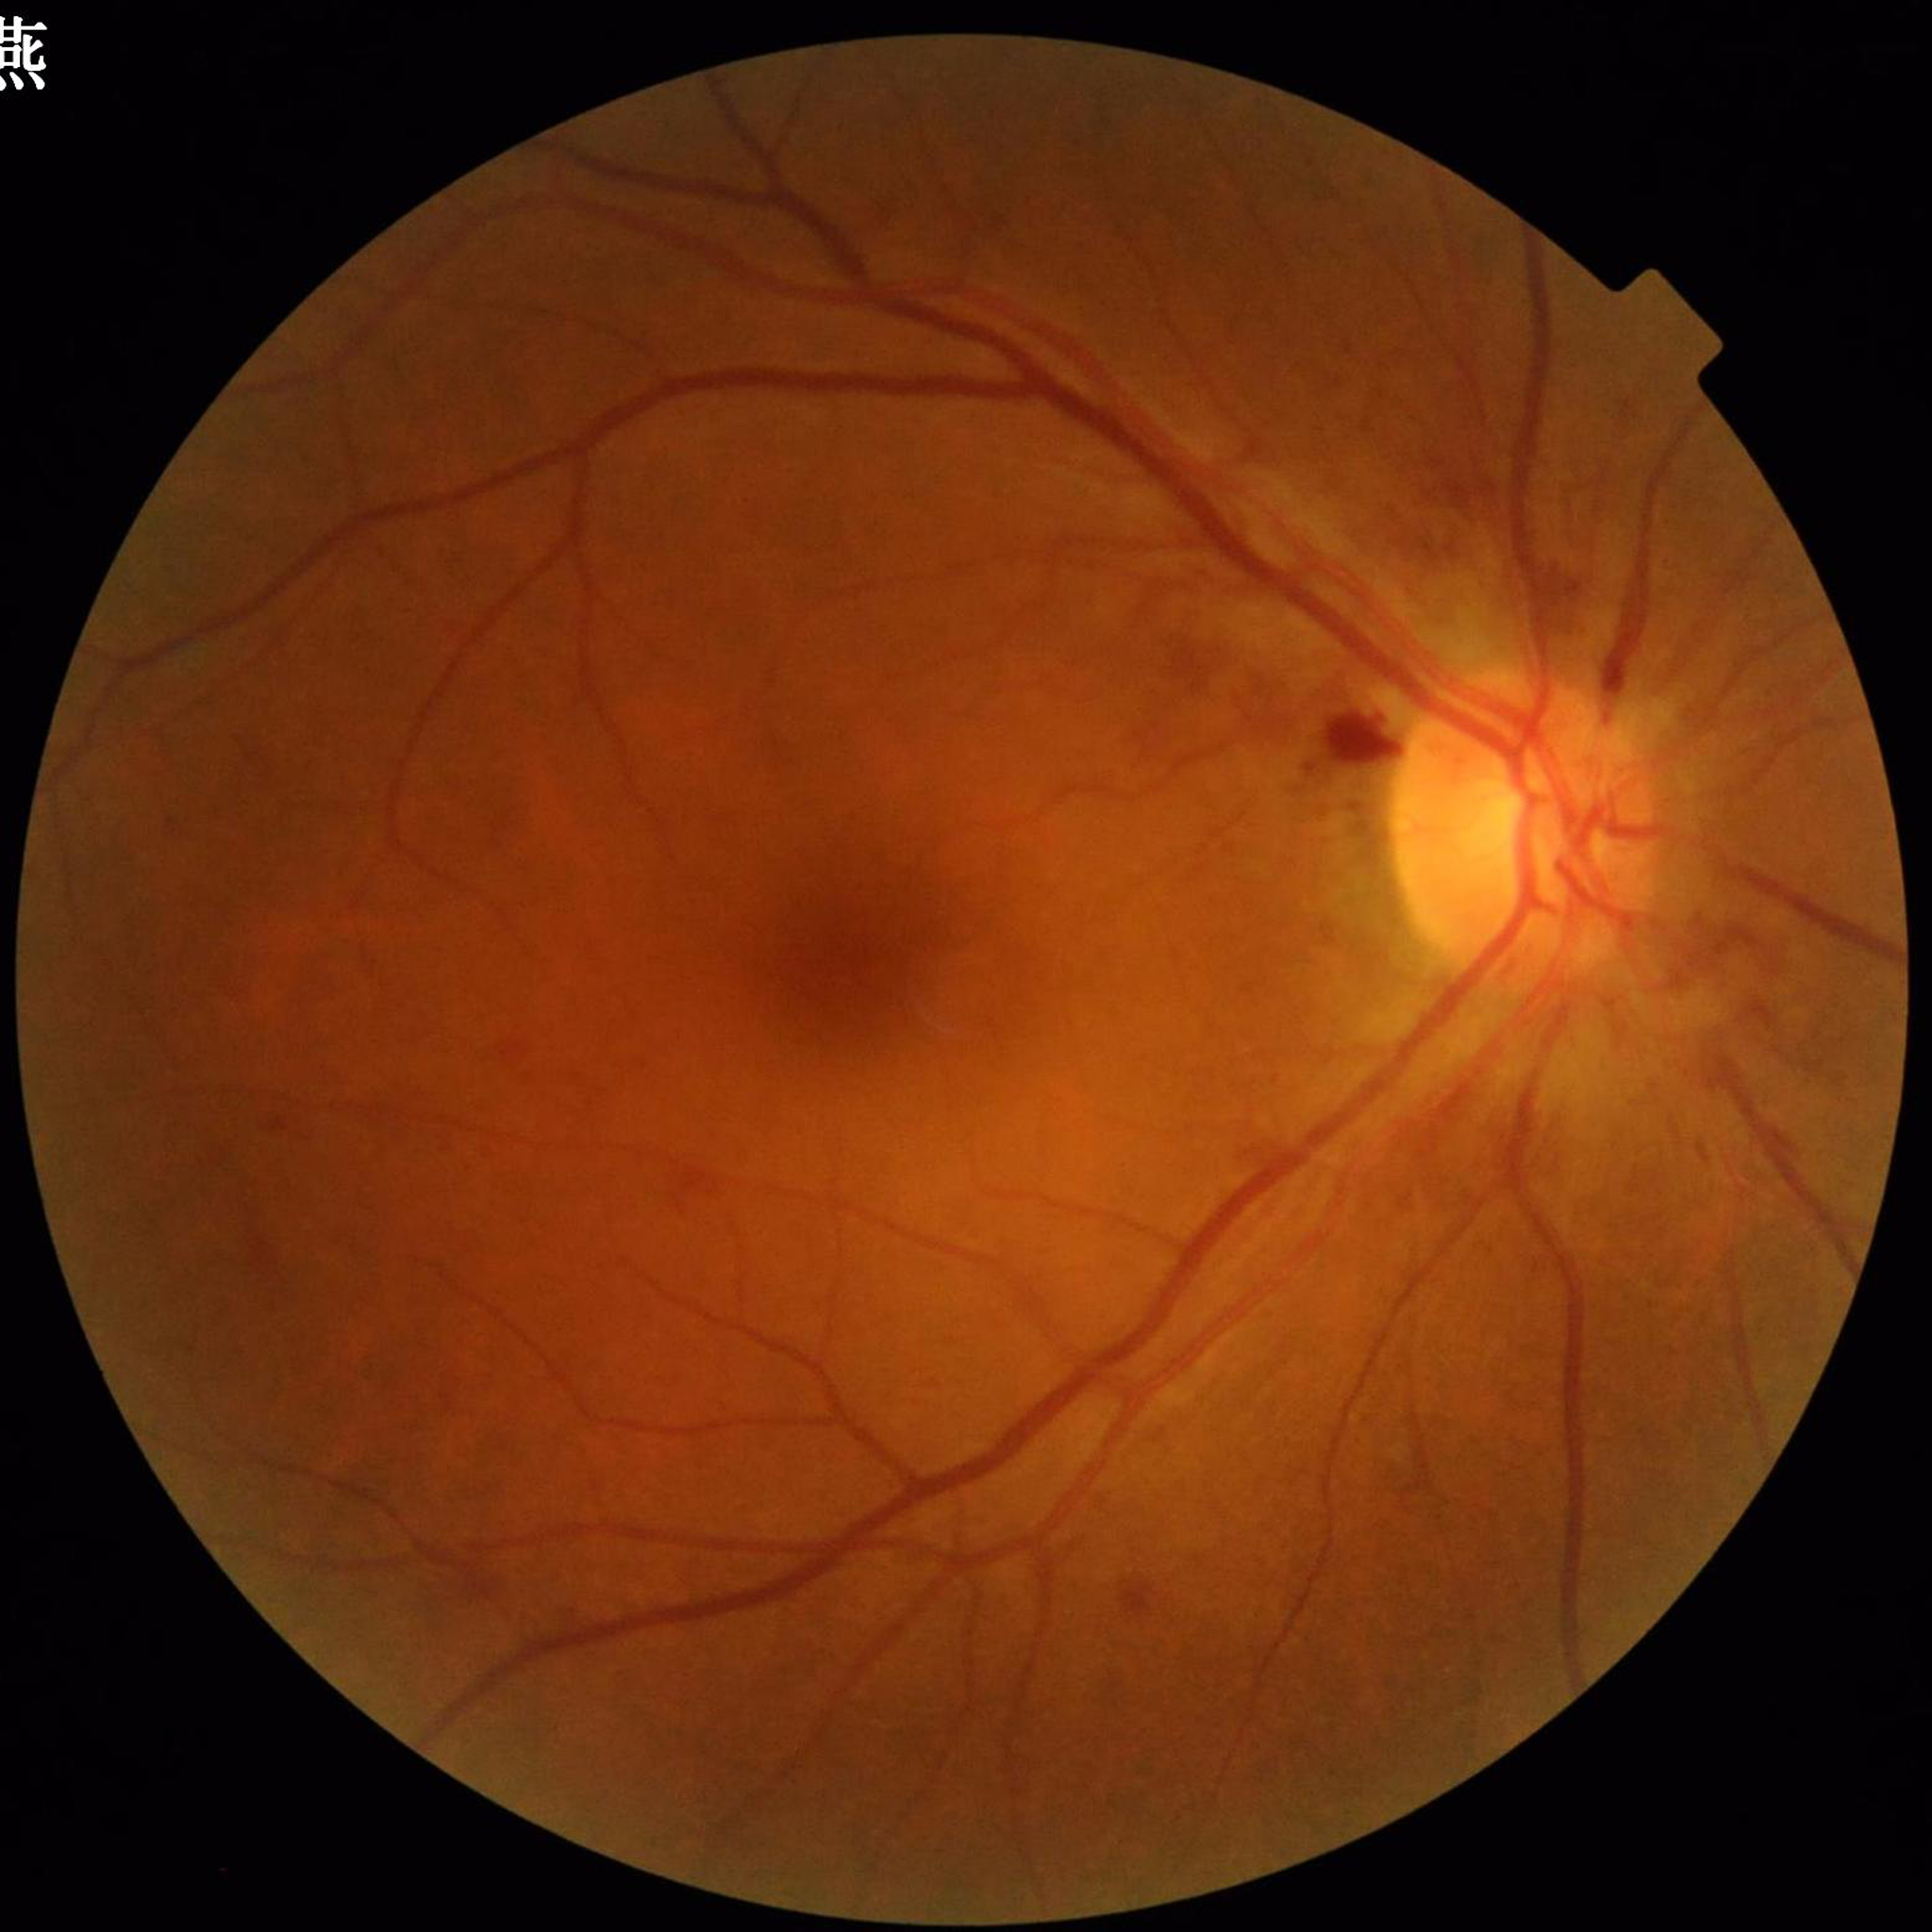
diagnosis: diabetic retinopathy (DR)